45-degree field of view; fundus photo:
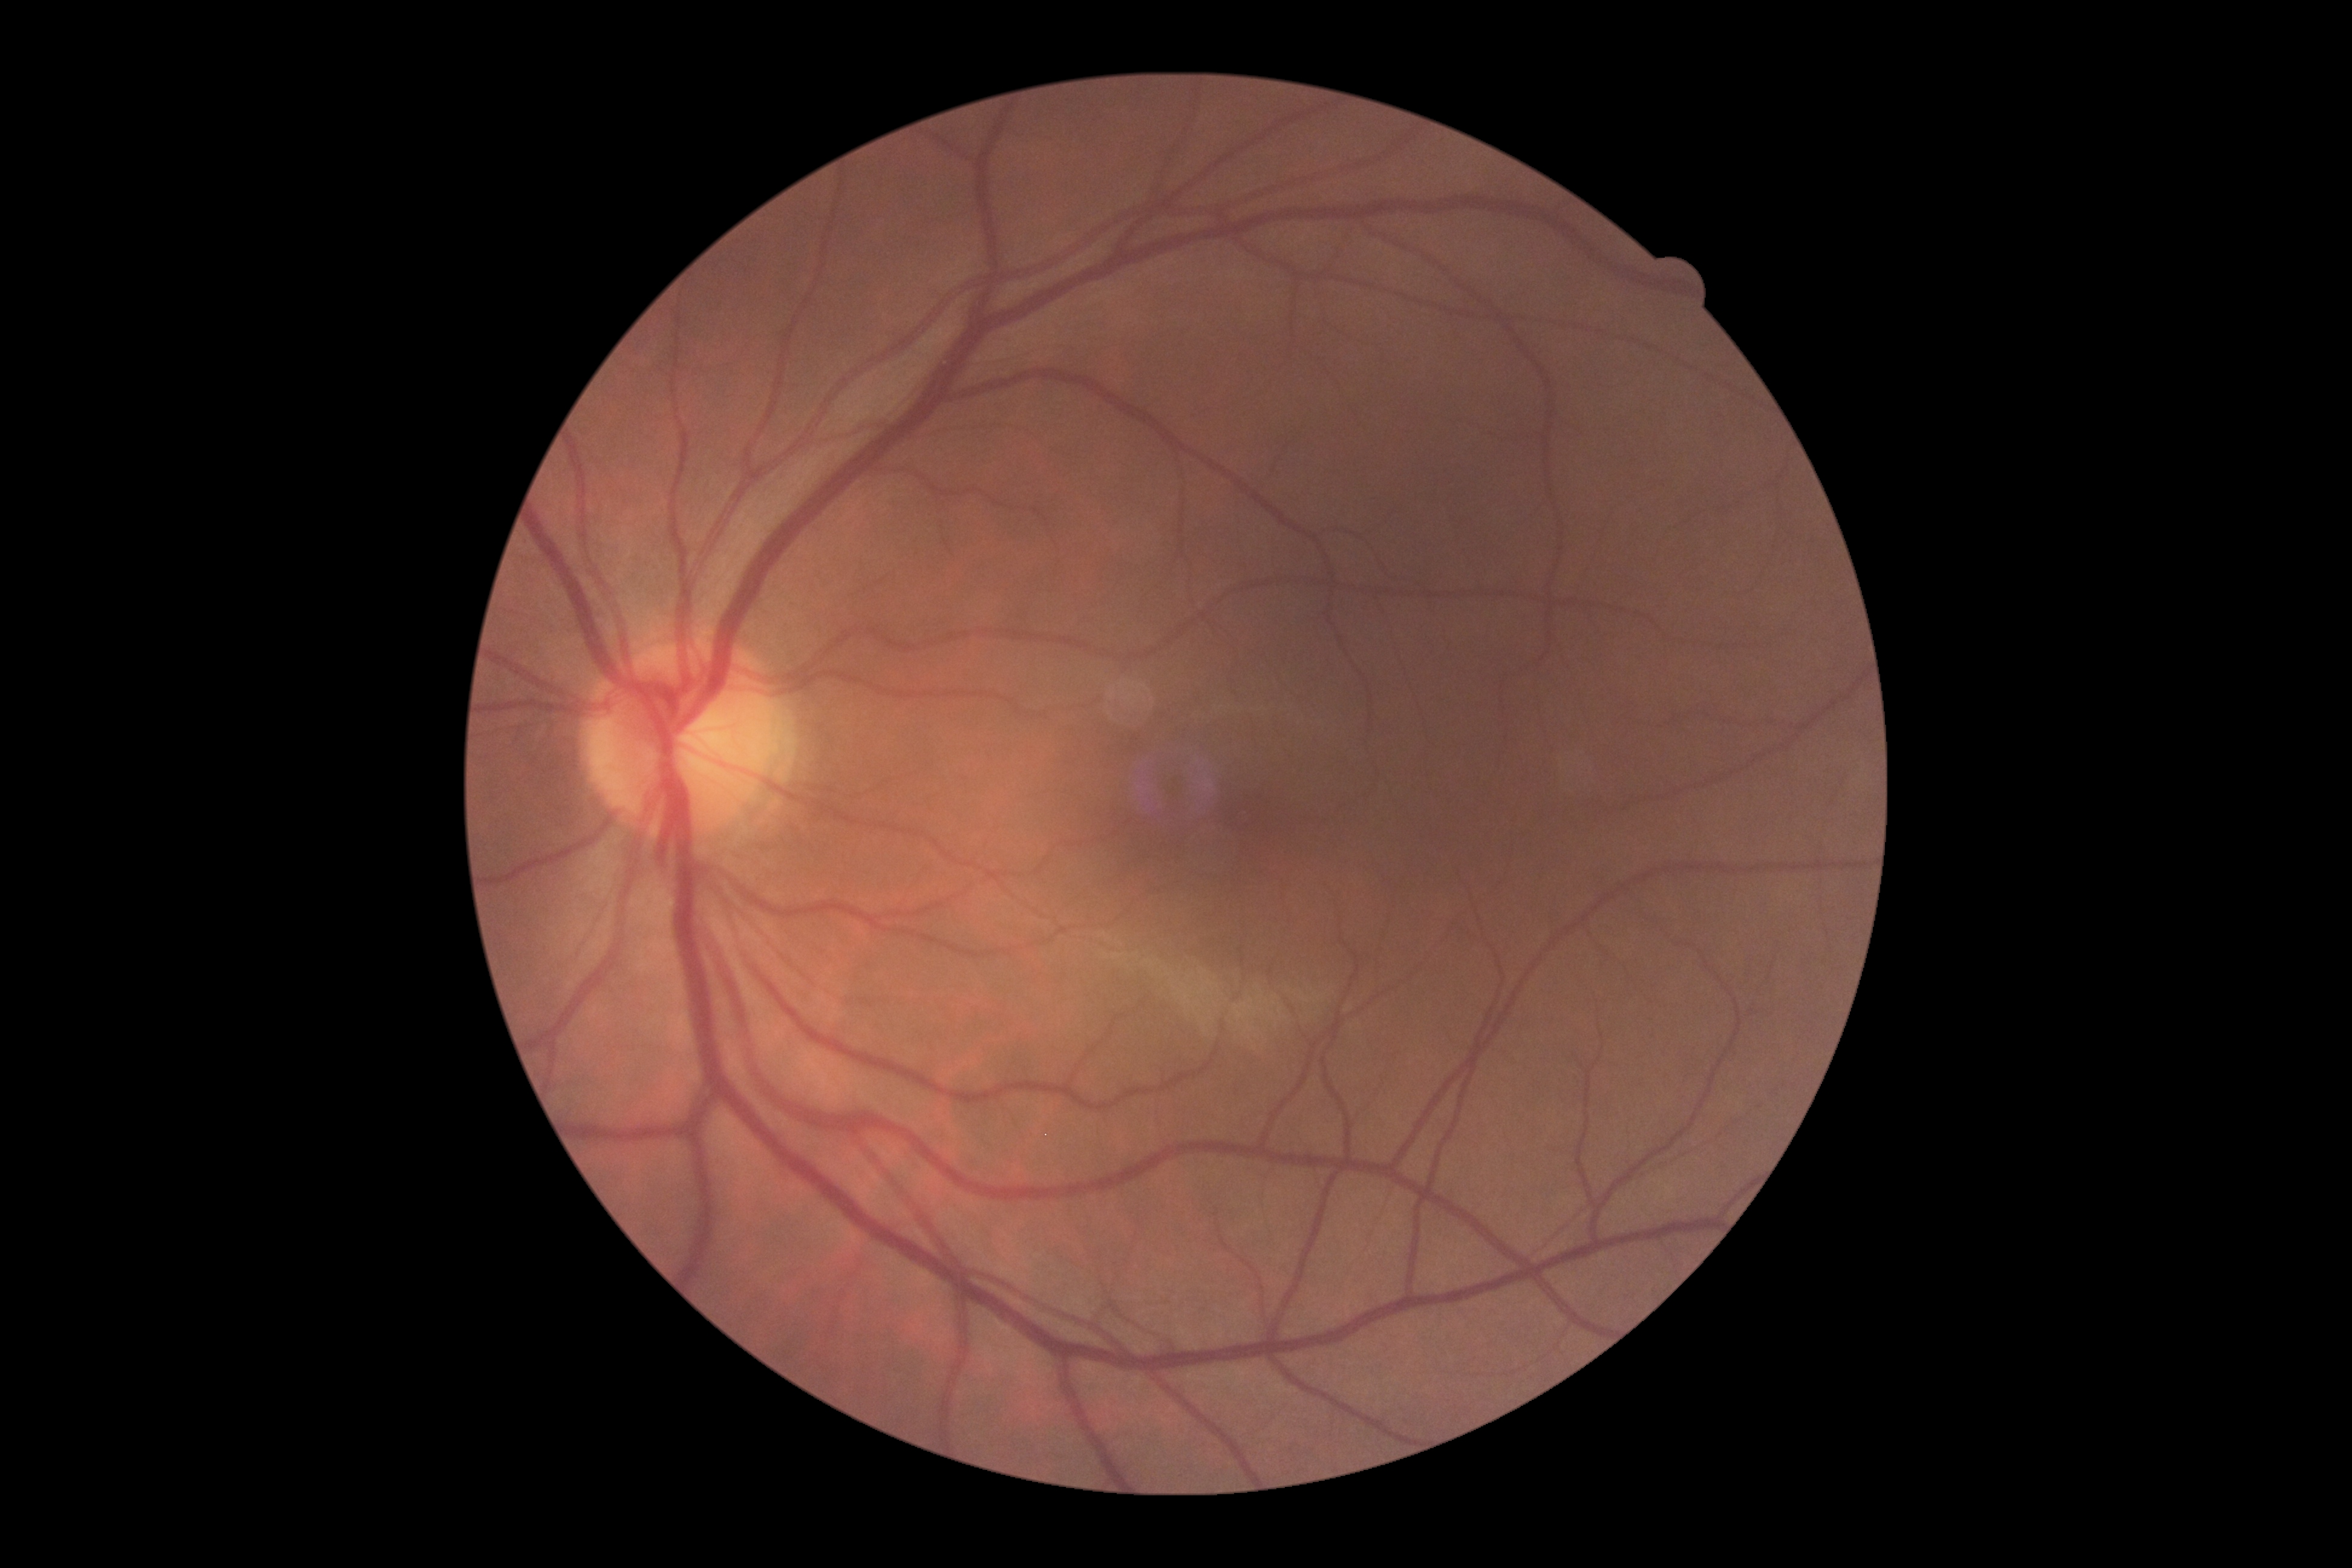 retinopathy: grade 0 (no apparent retinopathy).